Camera: Clarity RetCam 3 (130° FOV); image size 640x480; RetCam wide-field infant fundus image:
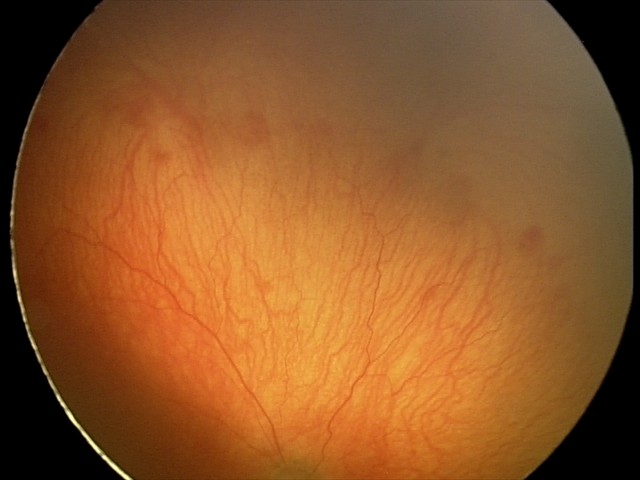
Plus disease was diagnosed.
Series diagnosed as aggressive retinopathy of prematurity.